NIDEK AFC-230 — 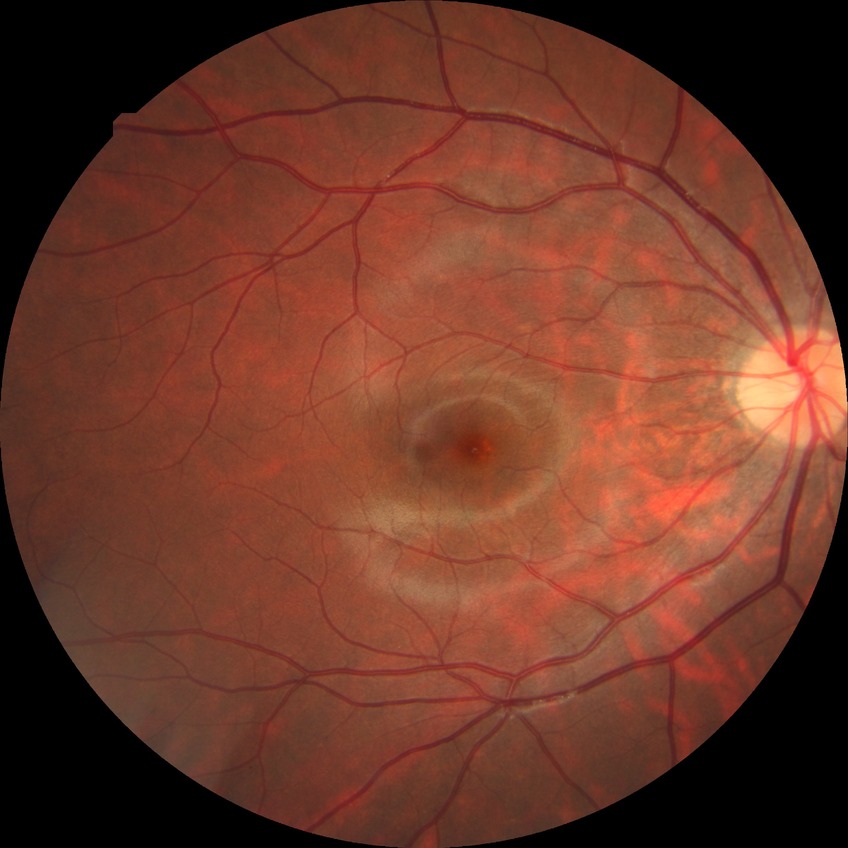

diabetic retinopathy (DR)@NDR (no diabetic retinopathy).